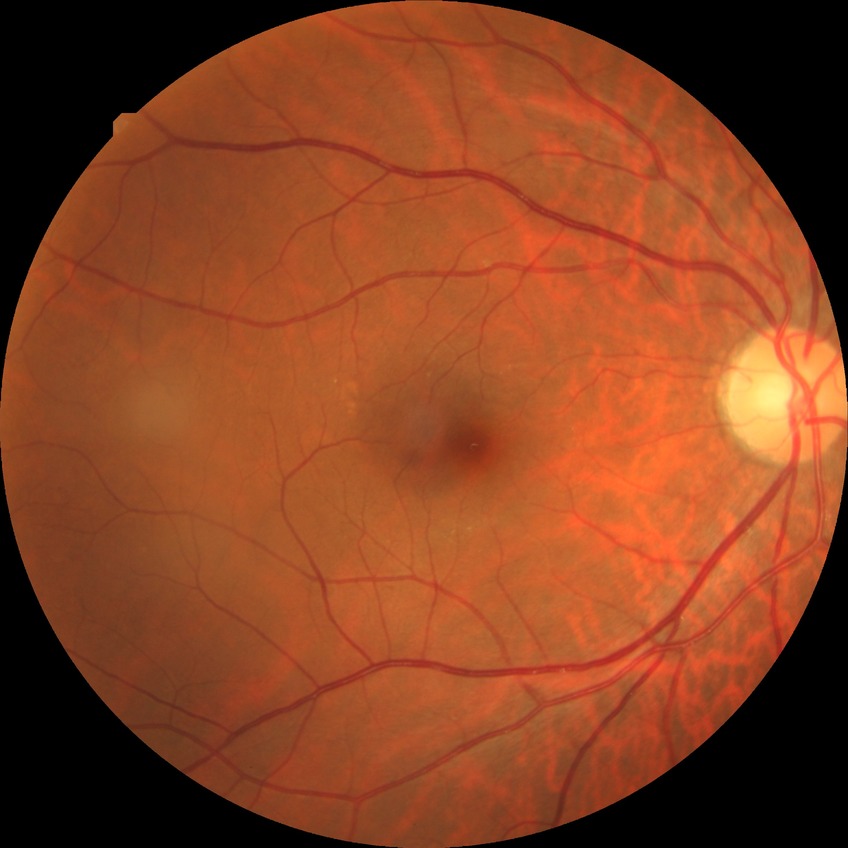 DR grade: NDR. No DR findings.